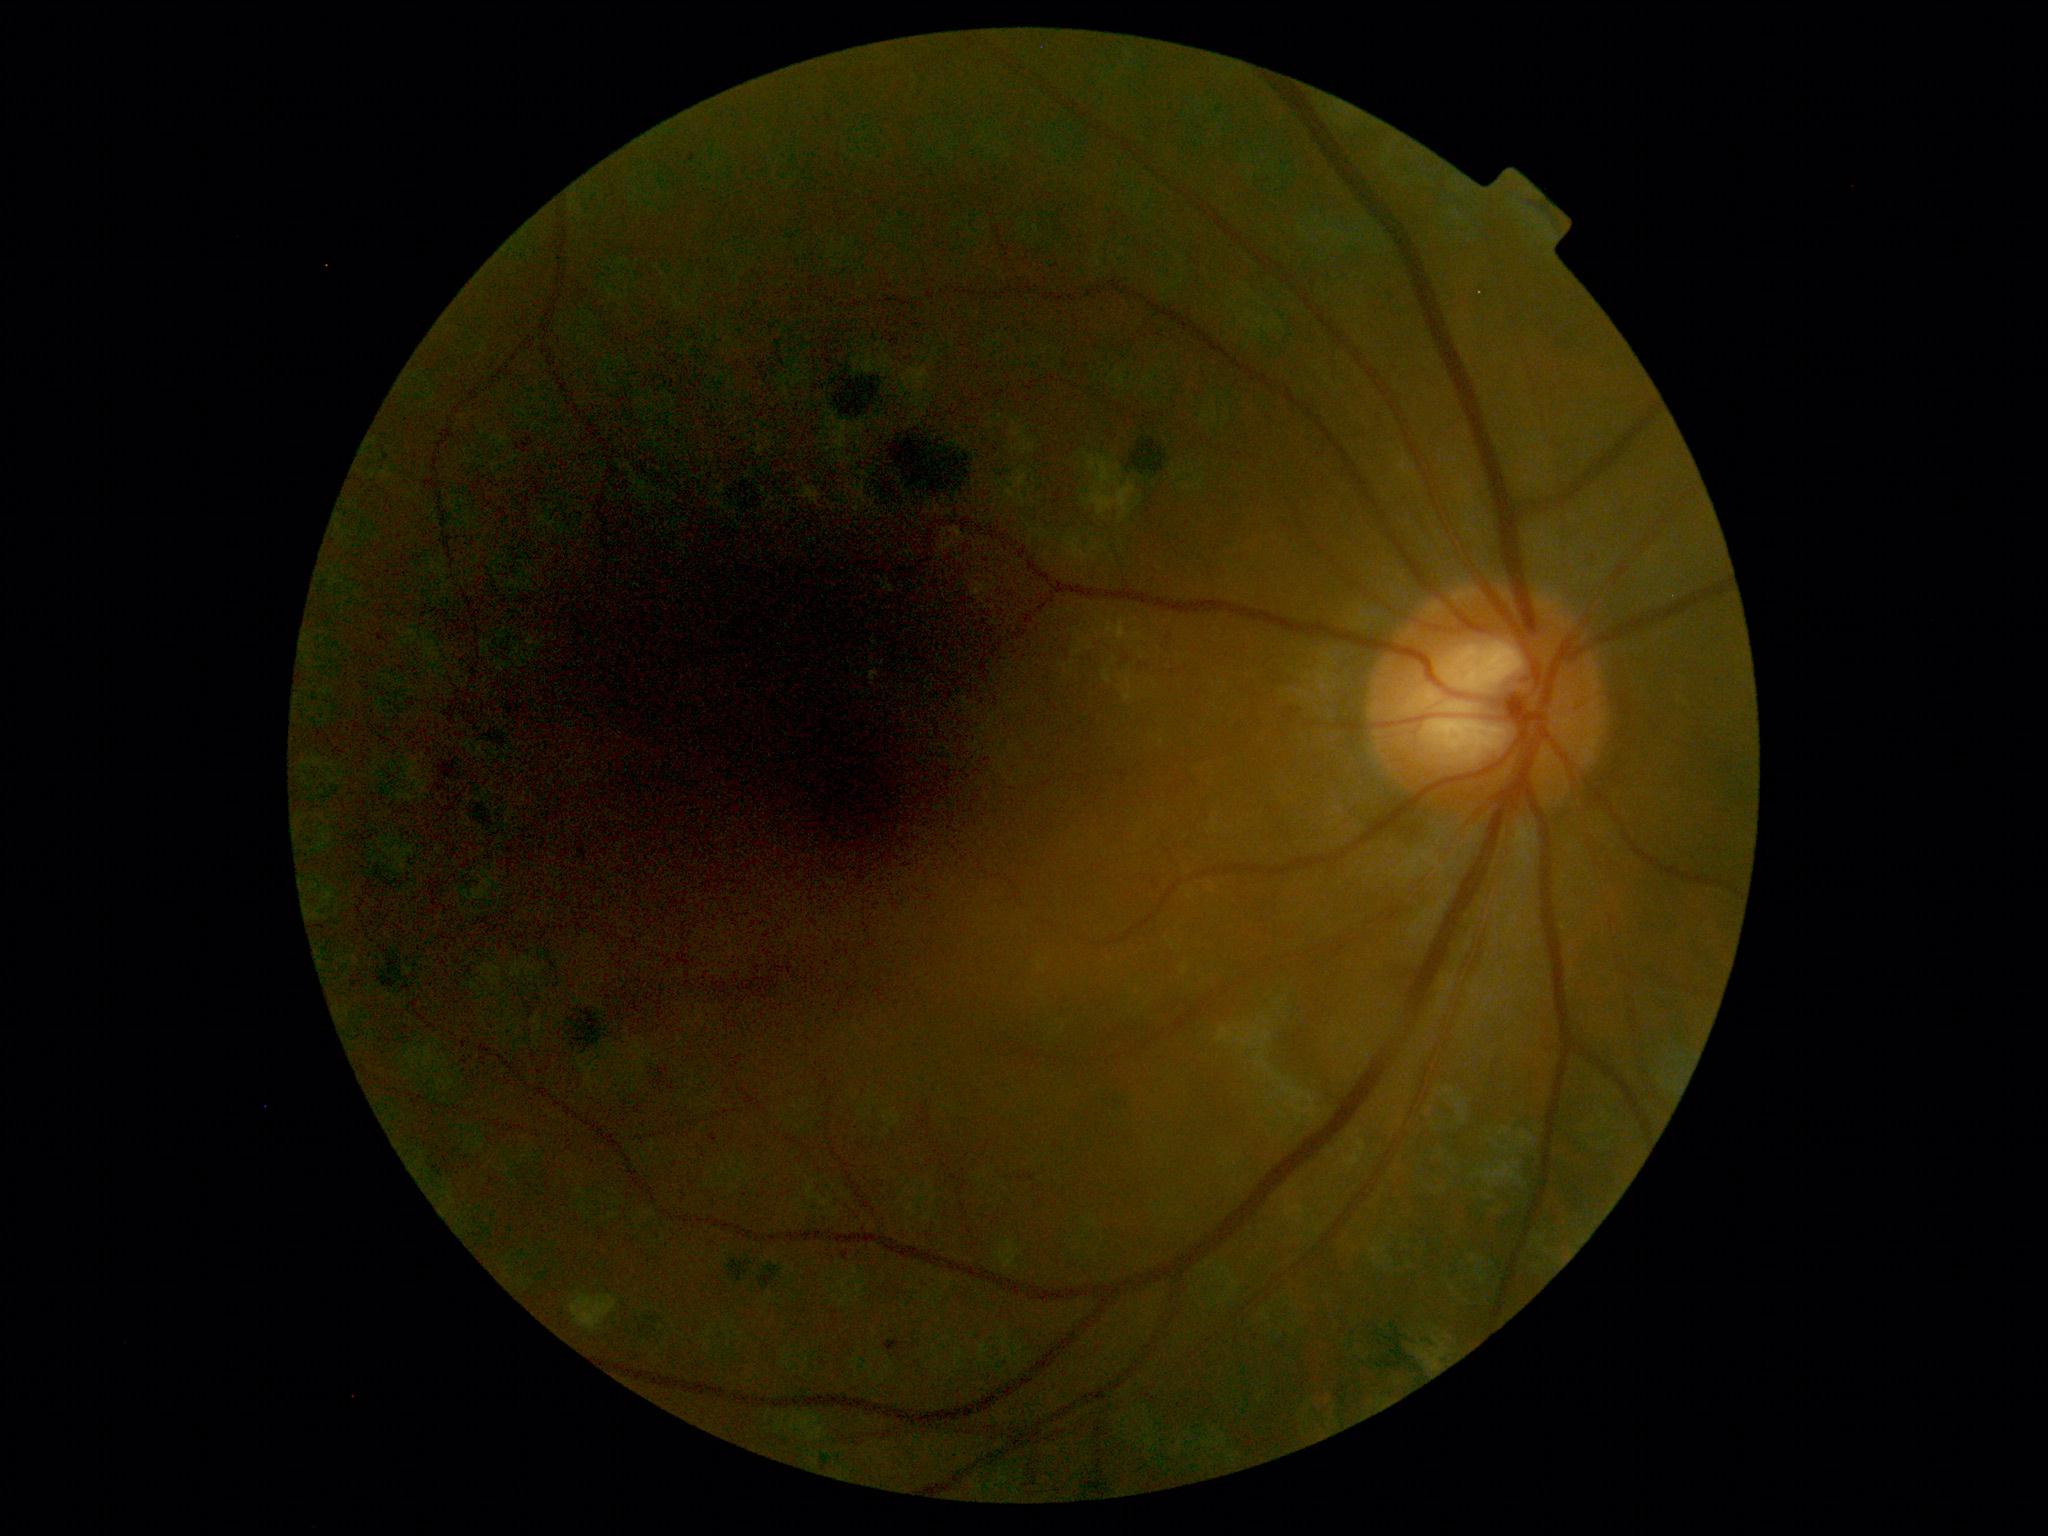
Findings:
- DR class — non-proliferative diabetic retinopathy
- DR severity — moderate NPDR (grade 2)